2352 x 1568 pixels: 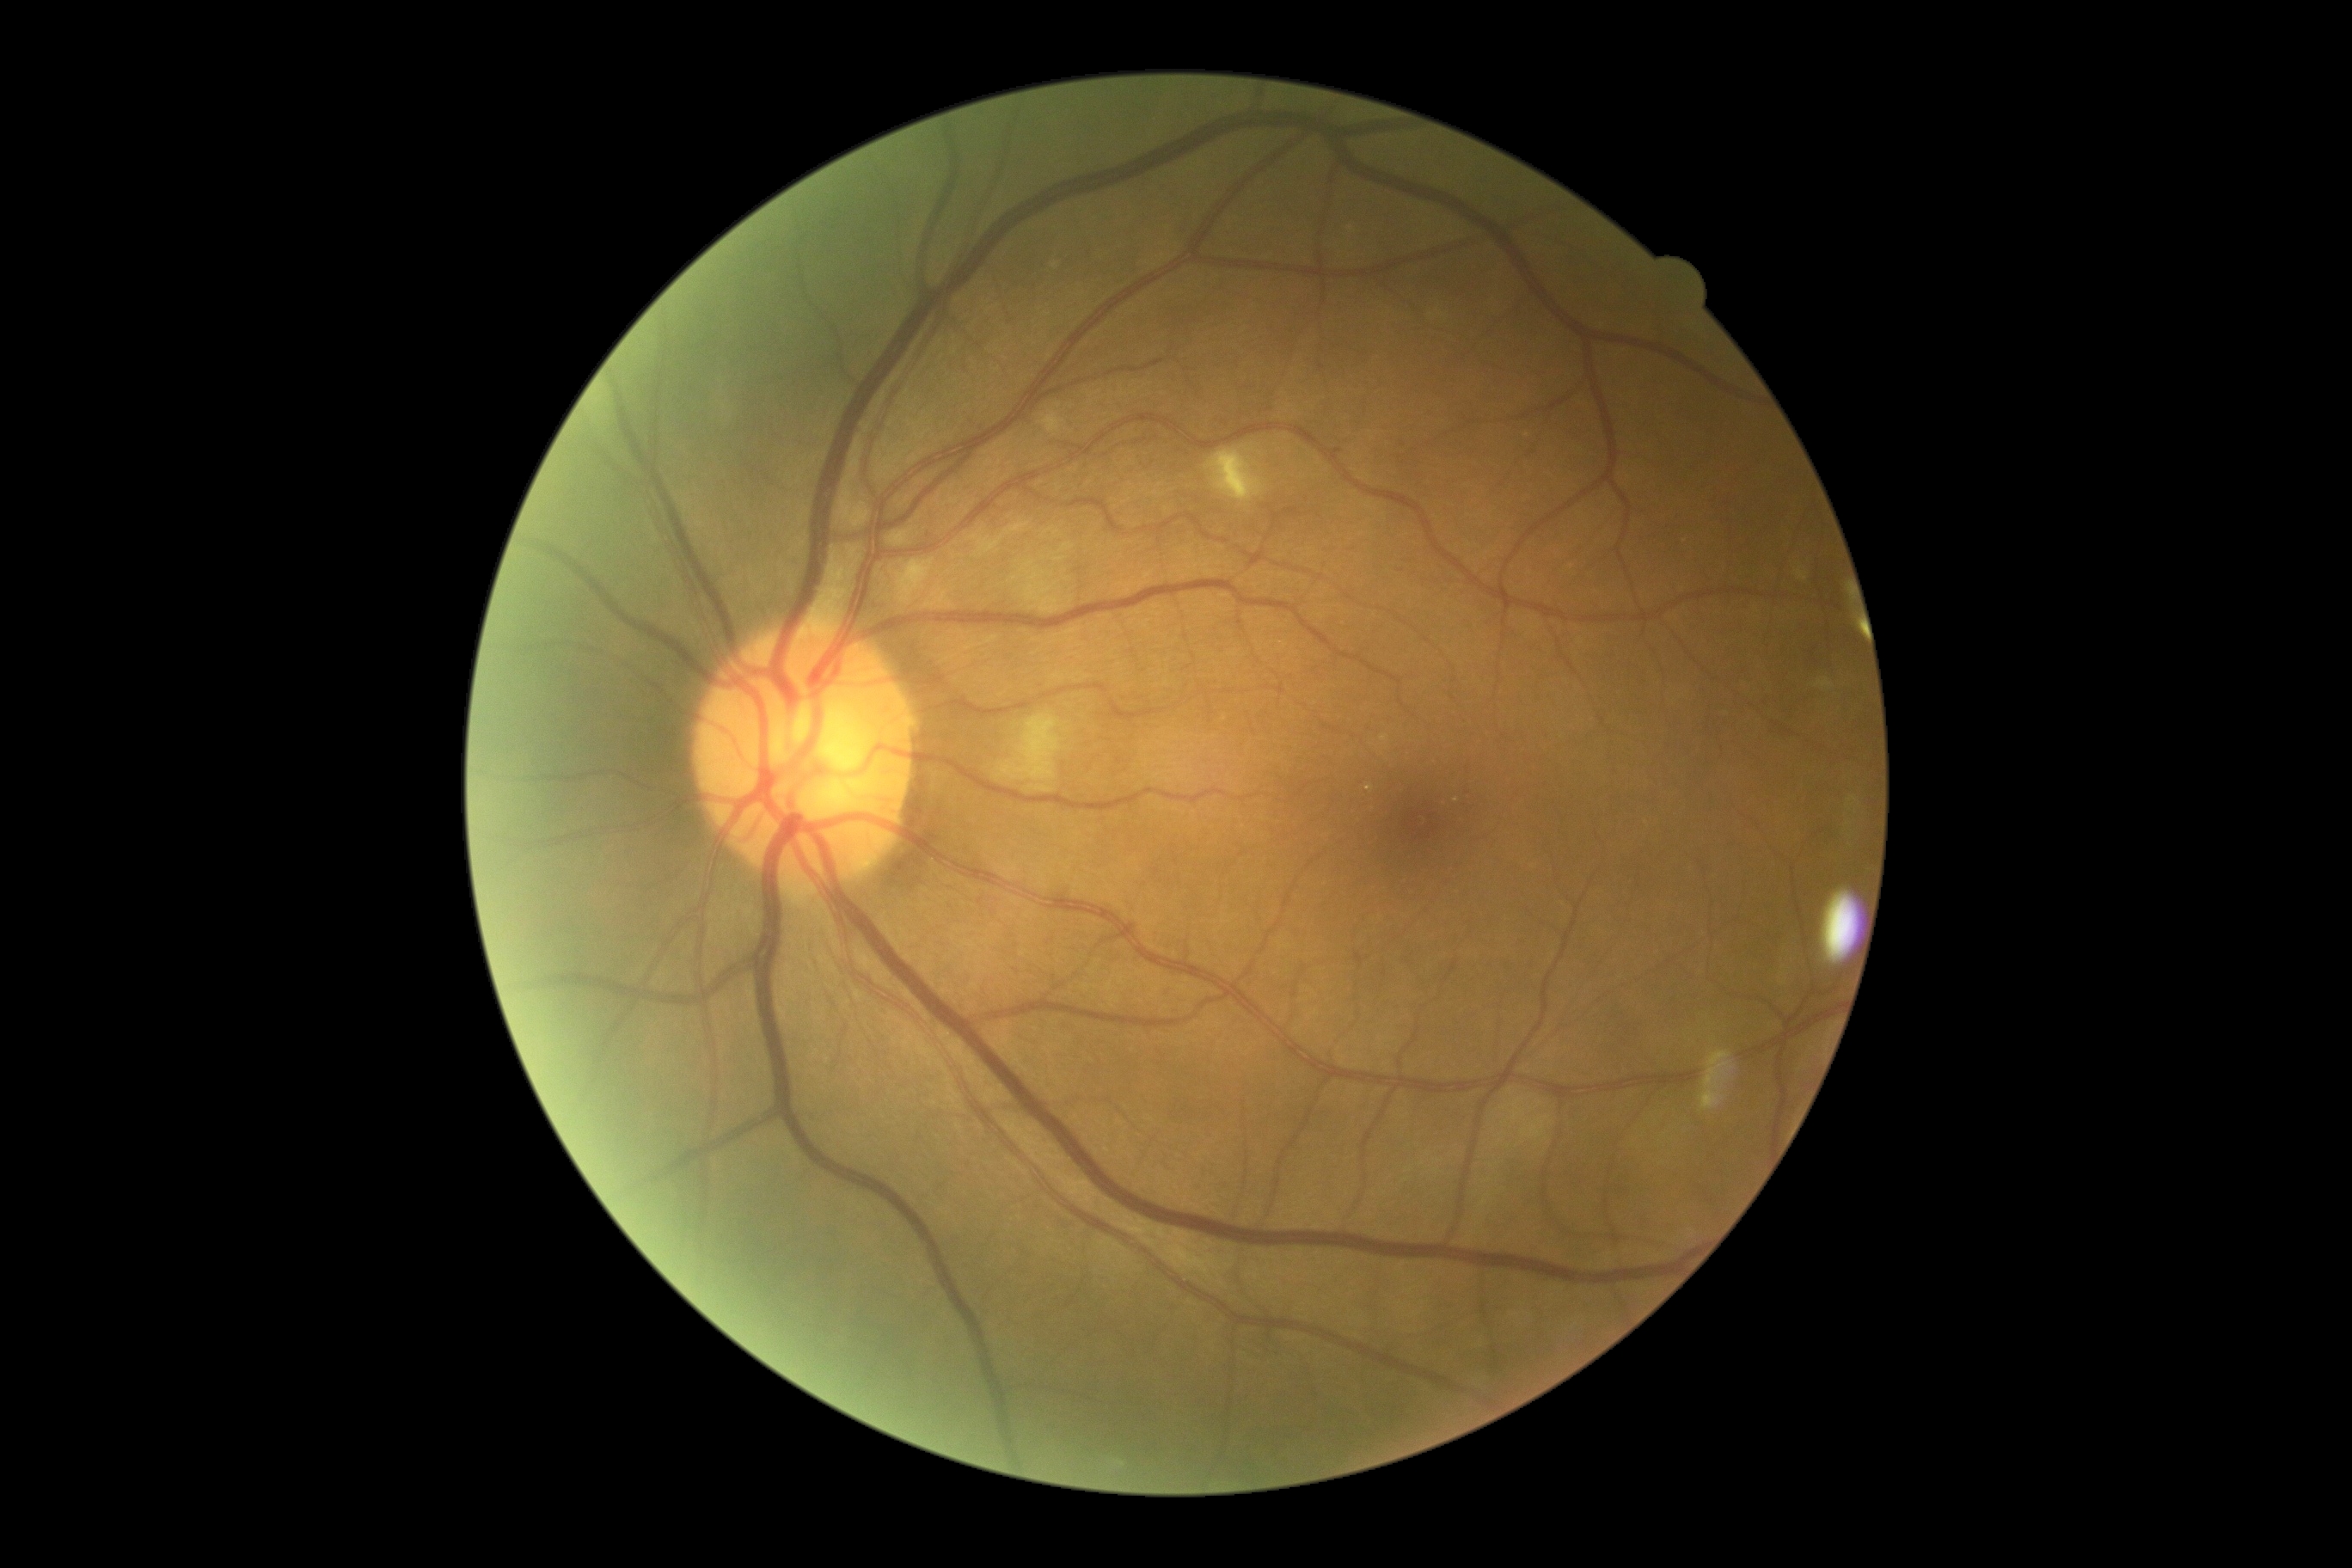
DR grade: 2.